CFP
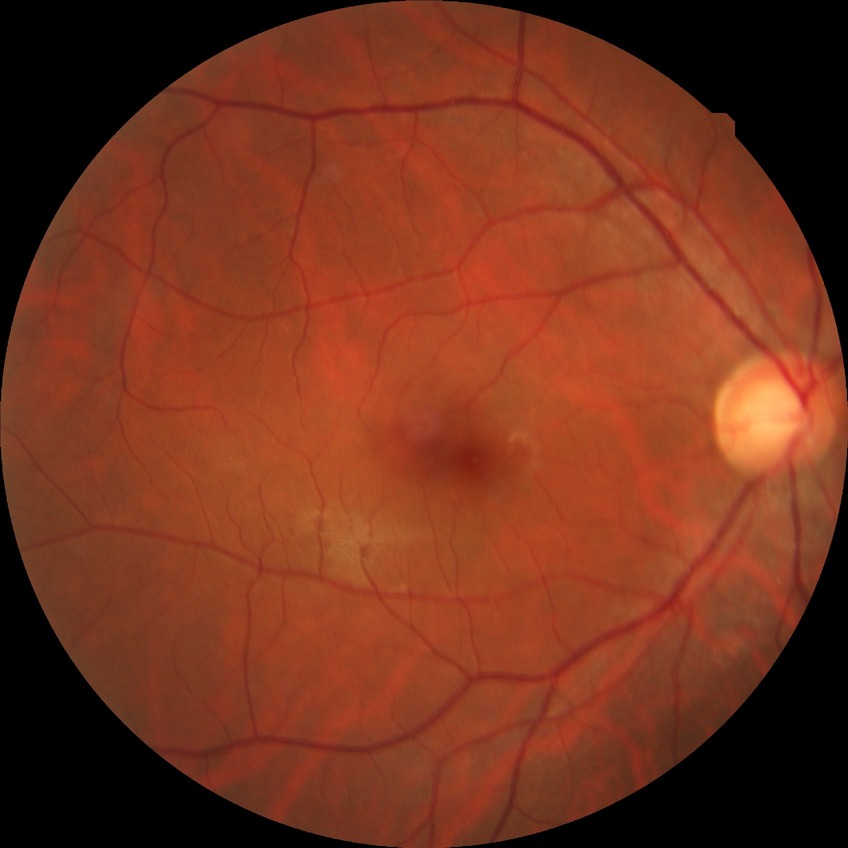
DR: NDR. No apparent diabetic retinopathy.